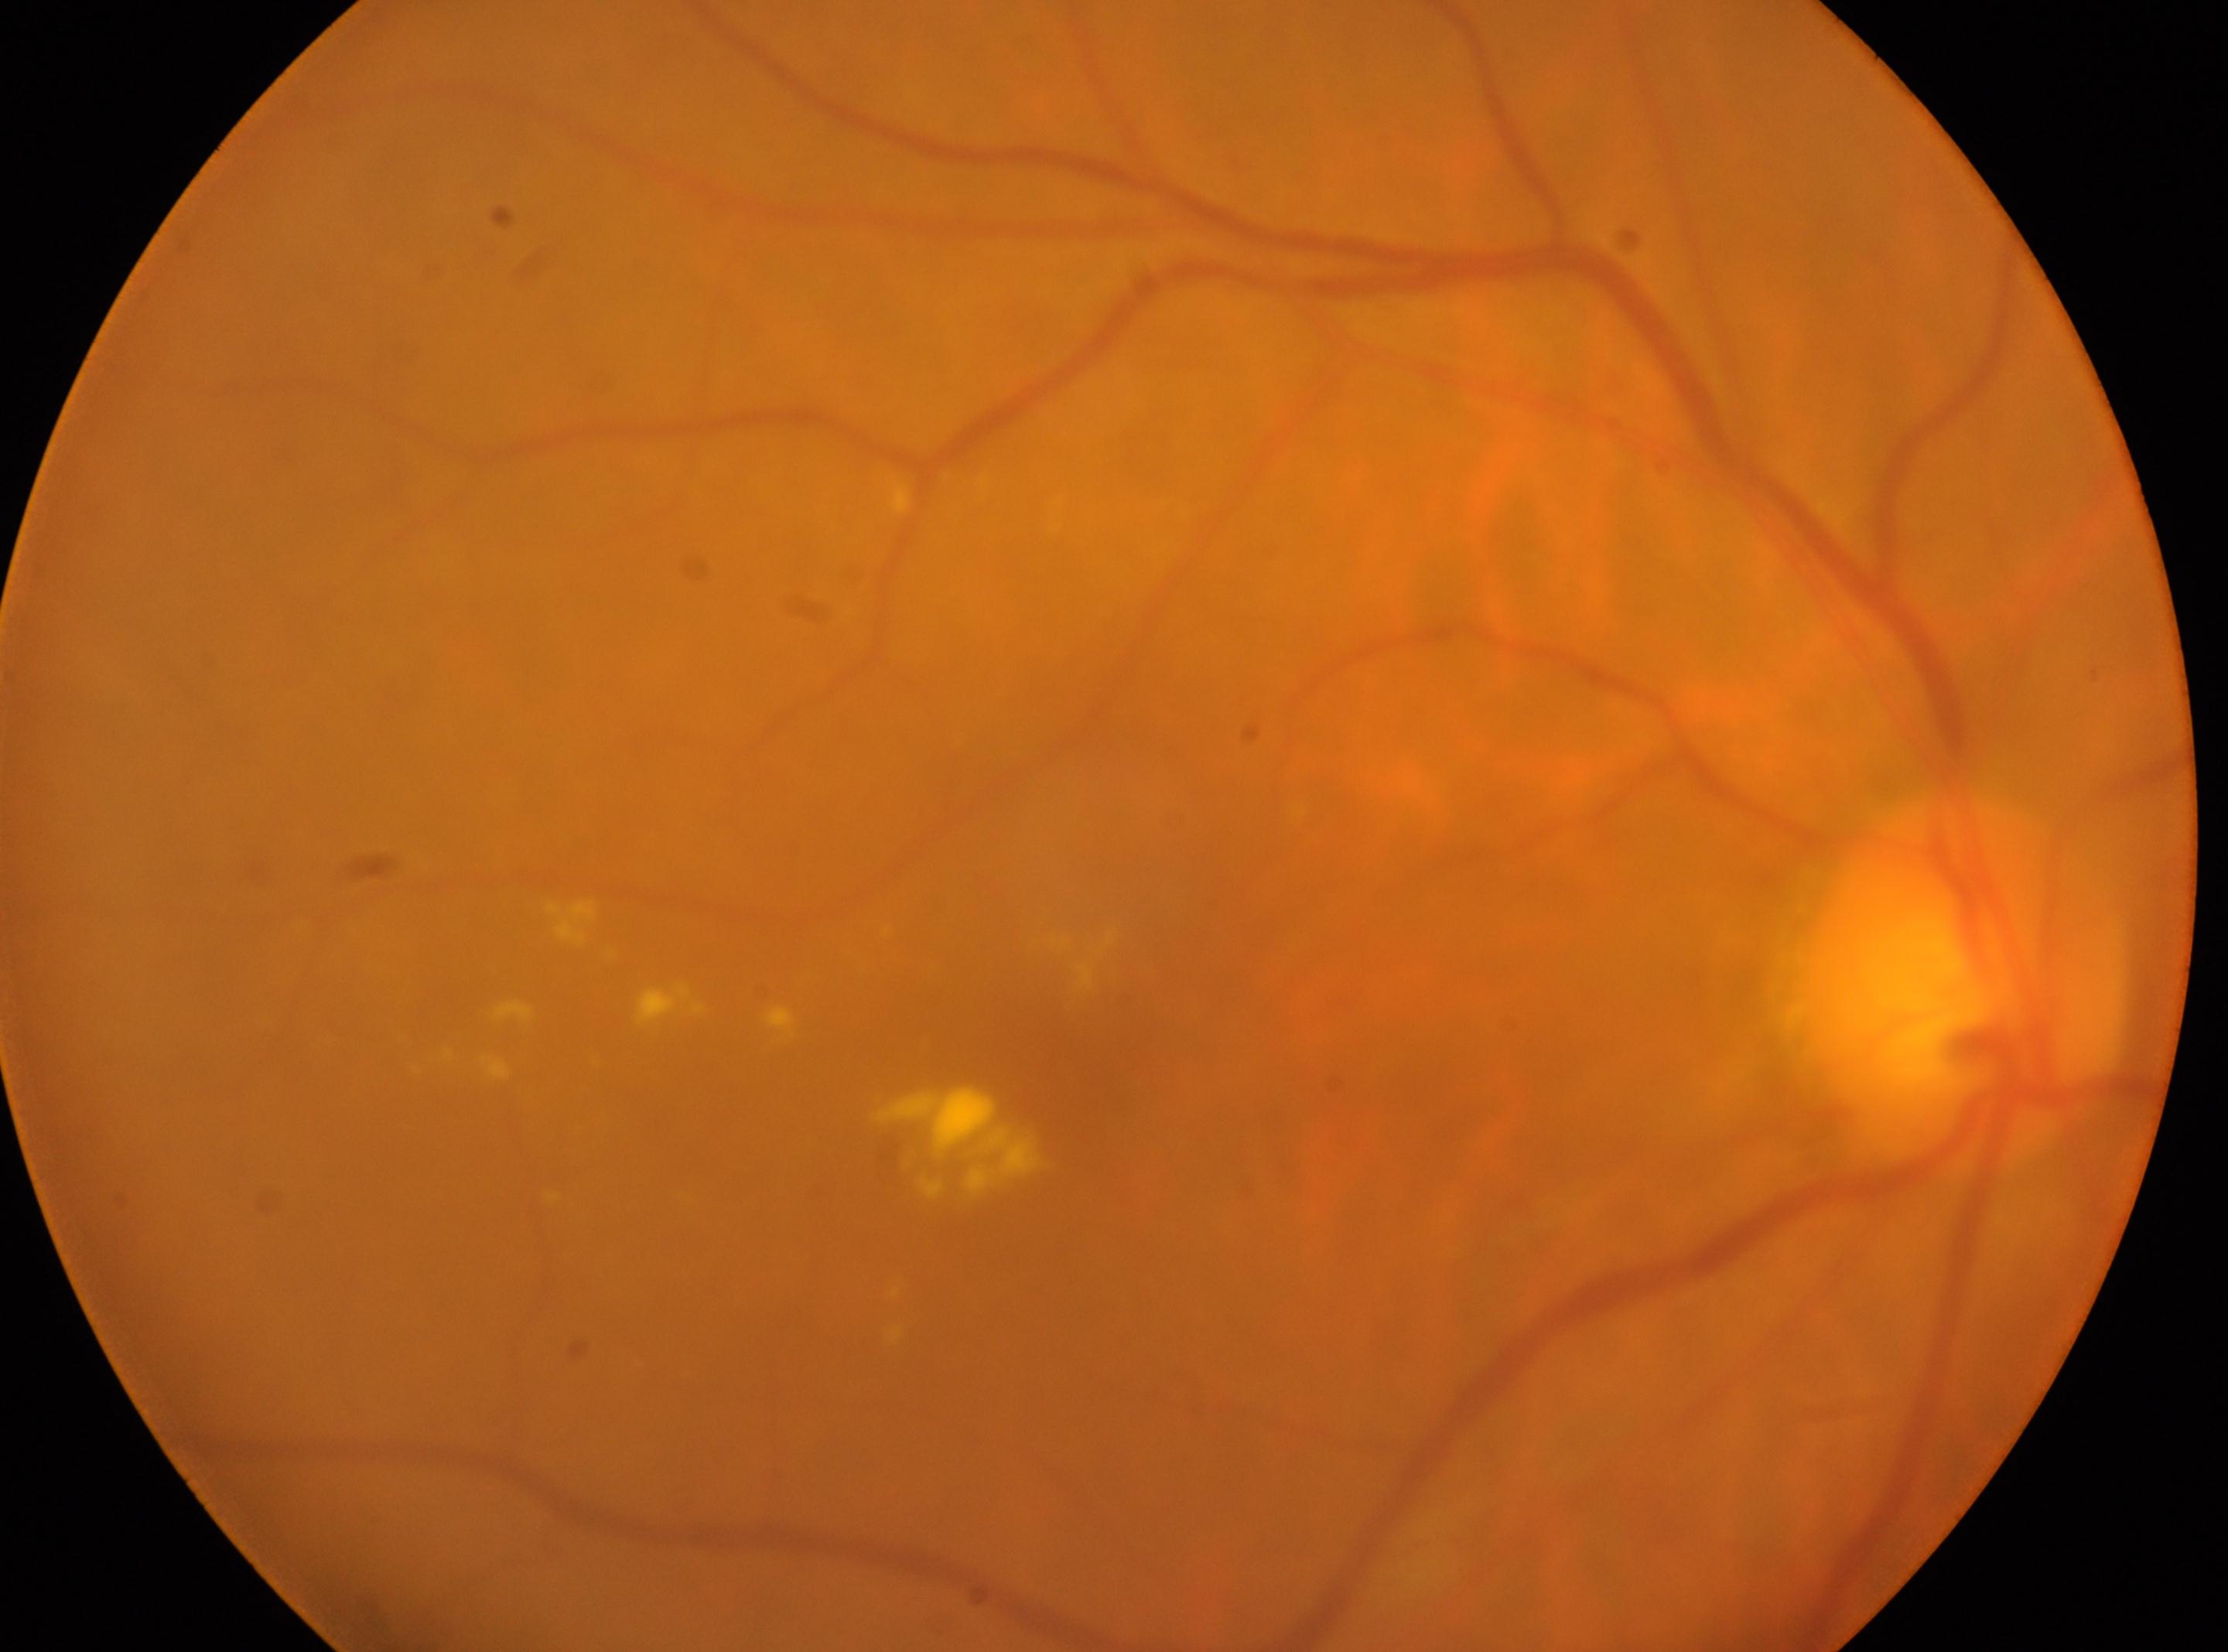
ONH@[1961, 991]
DR@2/4 — more than just microaneurysms but less than severe NPDR
oculus dexter
fovea center@[1075, 1058]